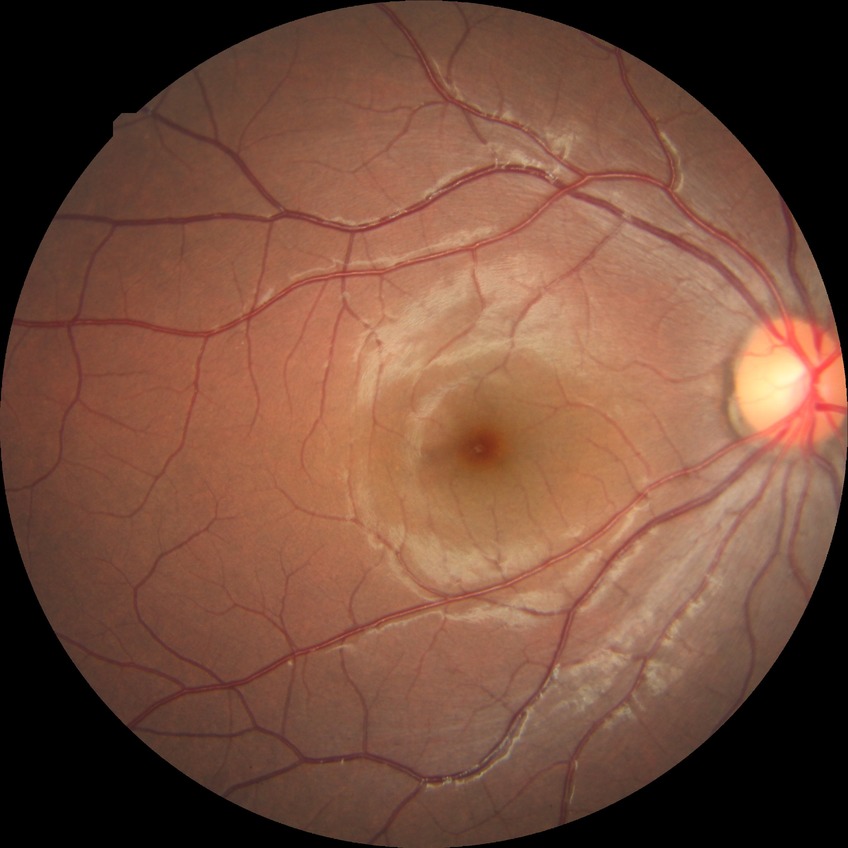
Diabetic retinopathy (DR): no diabetic retinopathy (NDR).